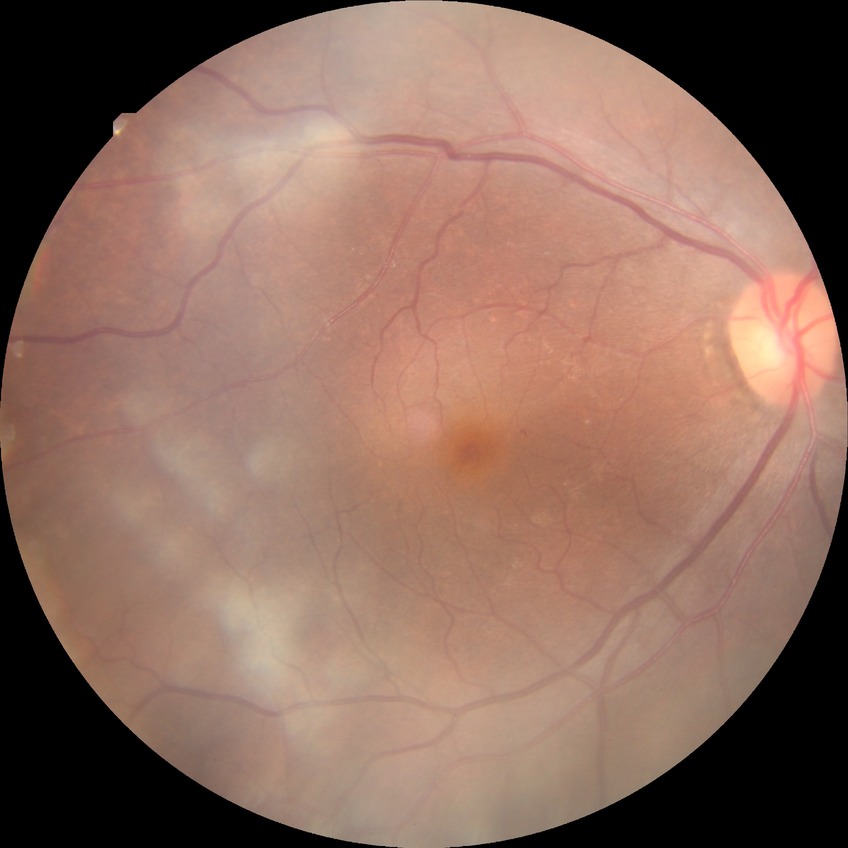

Annotations:
* diabetic retinopathy (DR) — simple diabetic retinopathy (SDR)